Camera: Remidio Fundus on Phone: 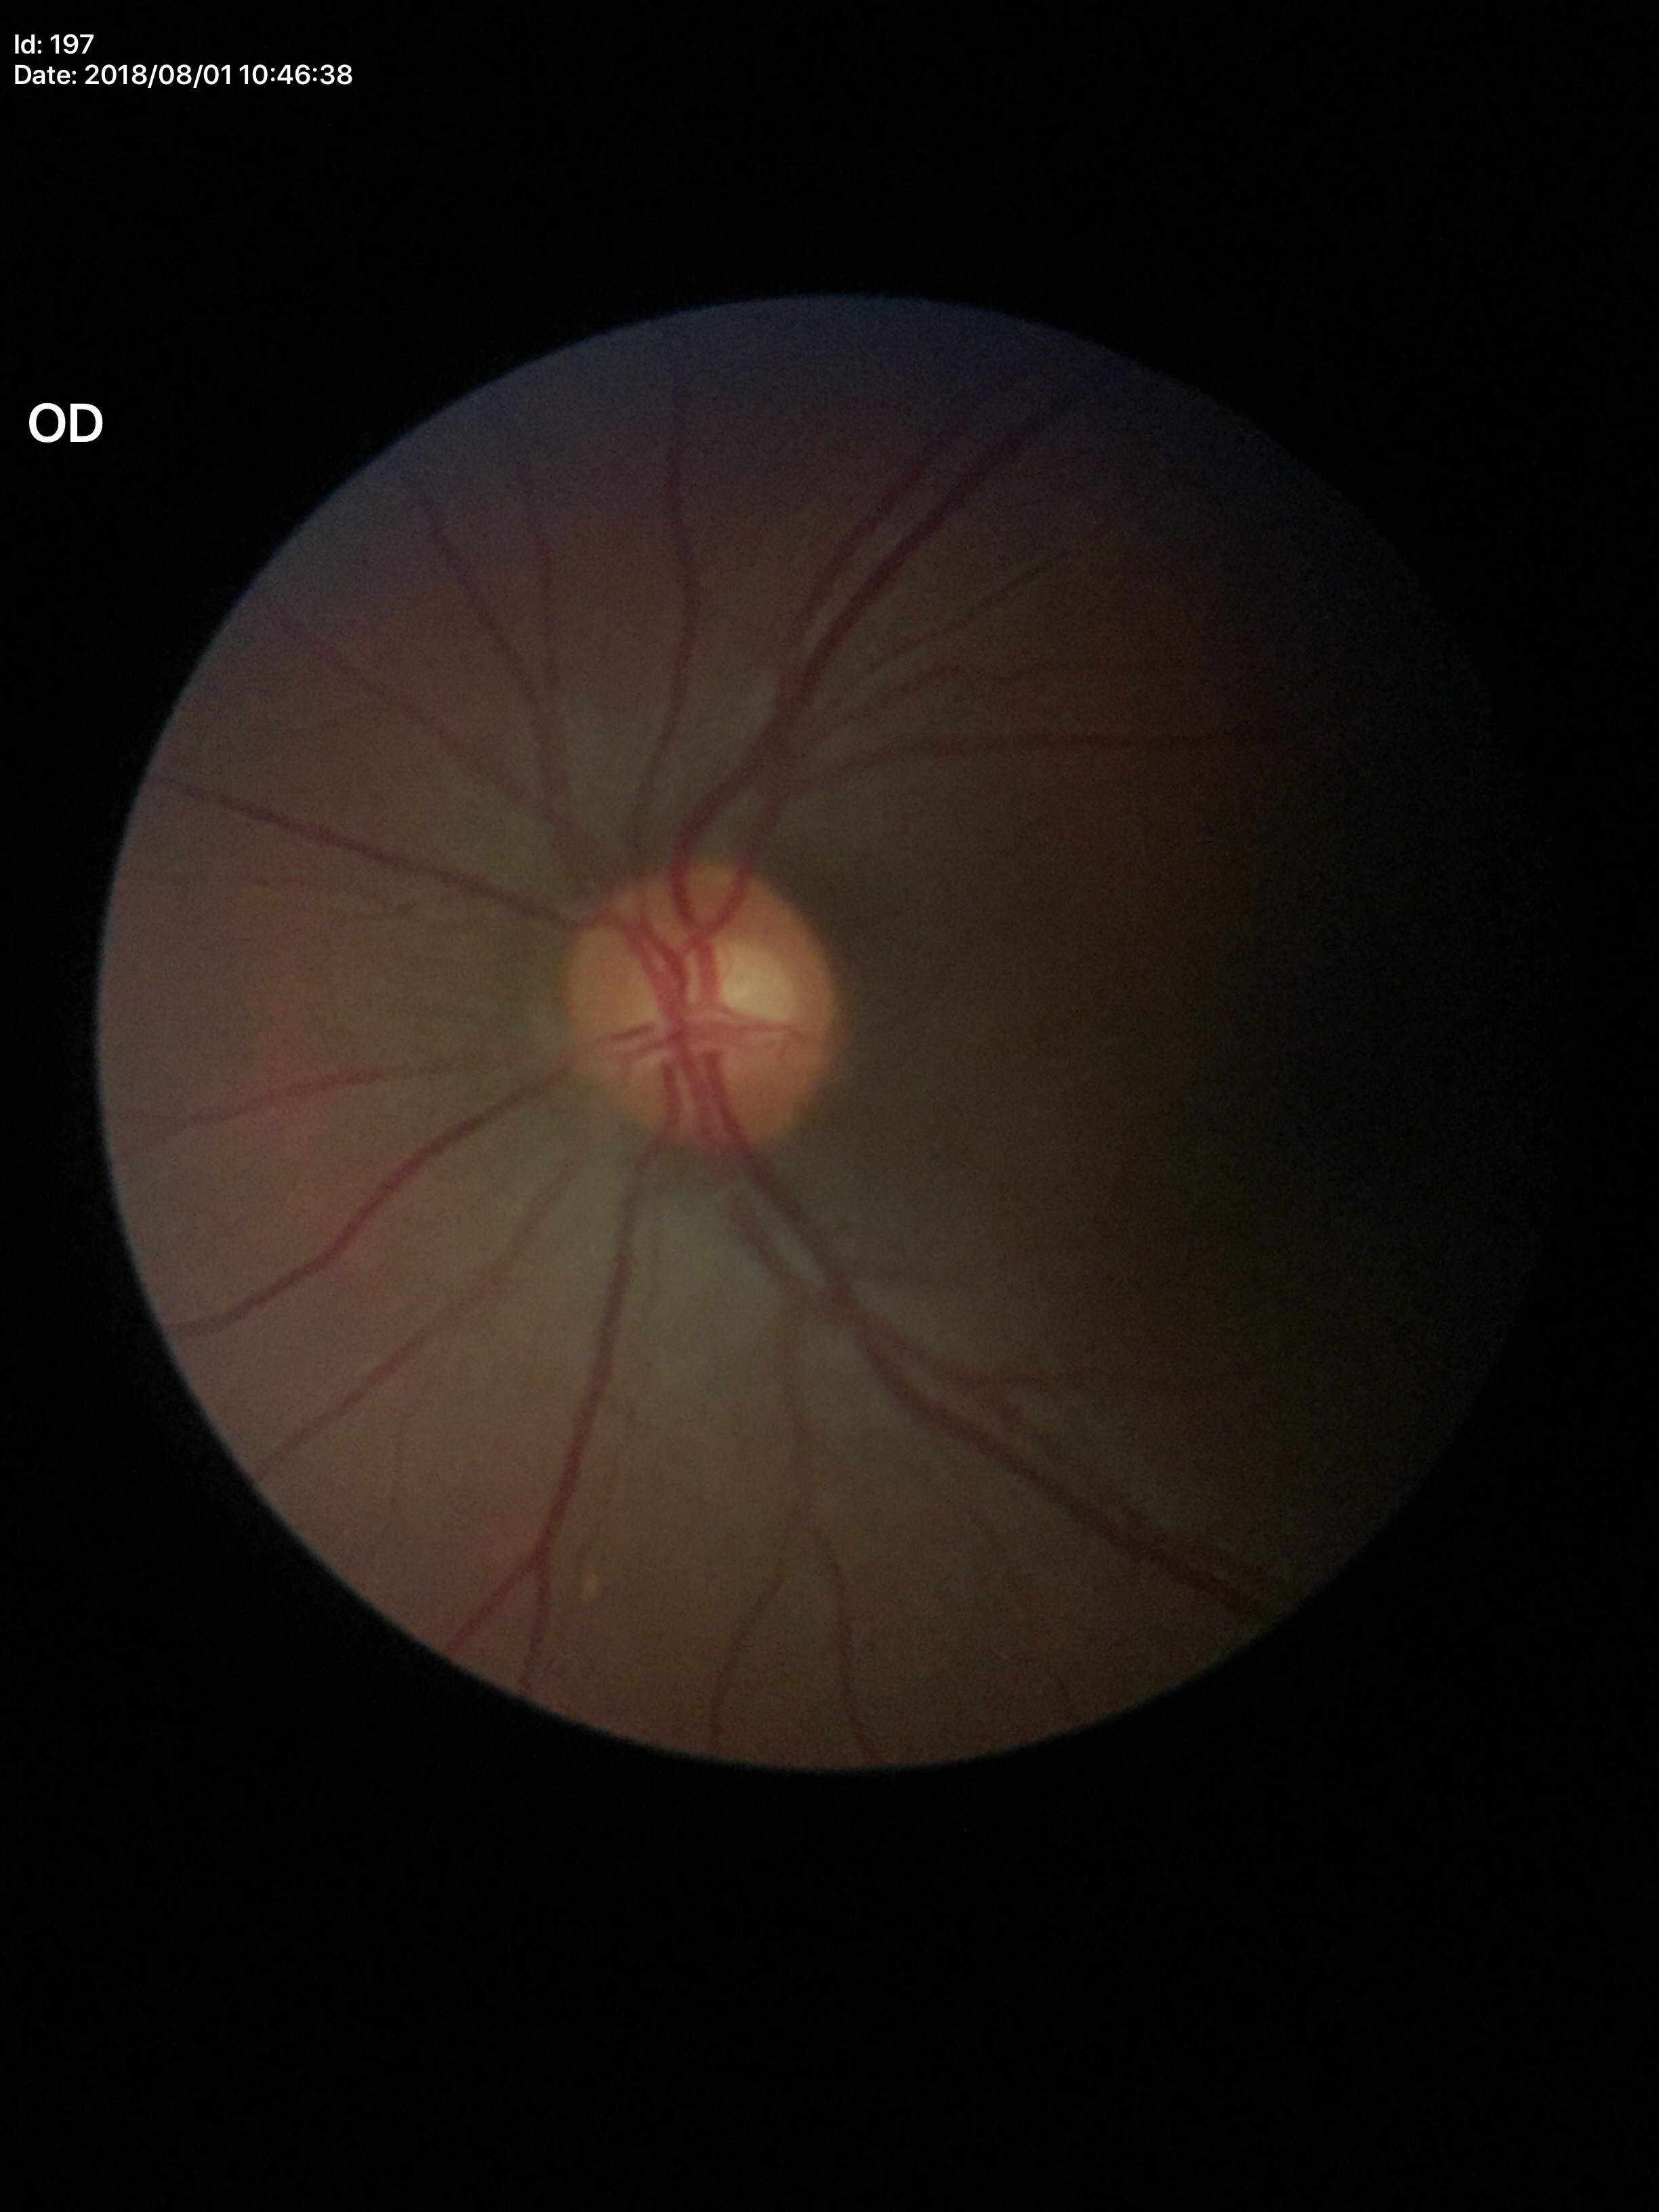

Glaucoma evaluation: no suspicious findings (all 5 graders called normal)
vertical cup-to-disc ratio (VCDR): 0.54
area cup-disc ratio (ACDR): 0.33